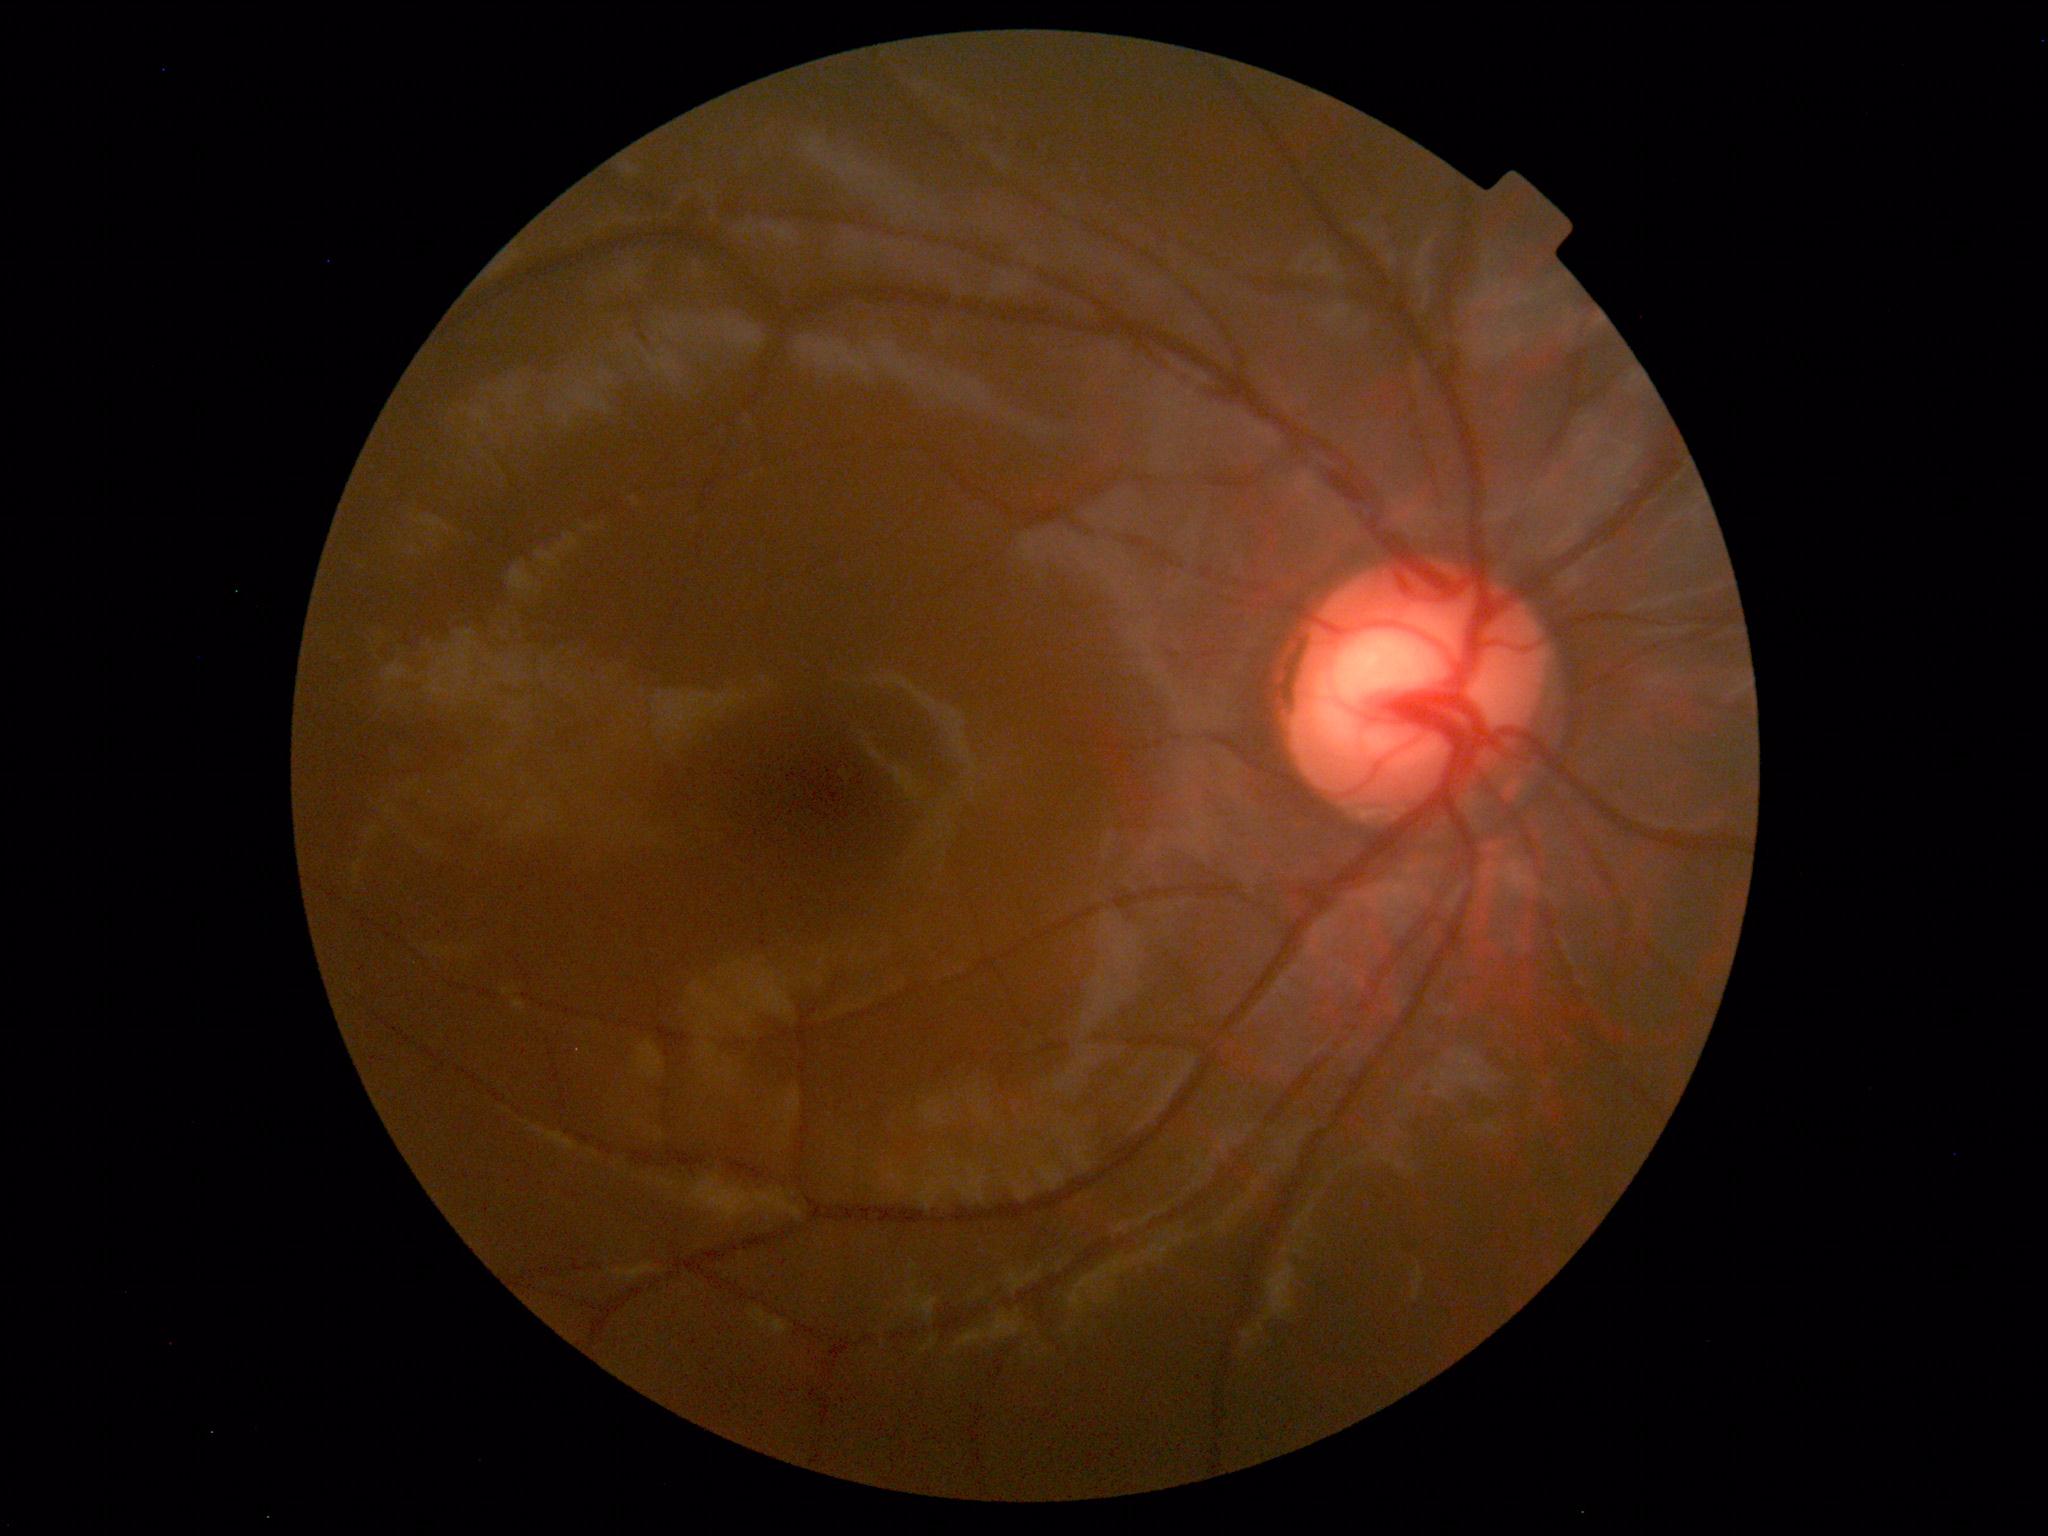 Impression: within normal limits.